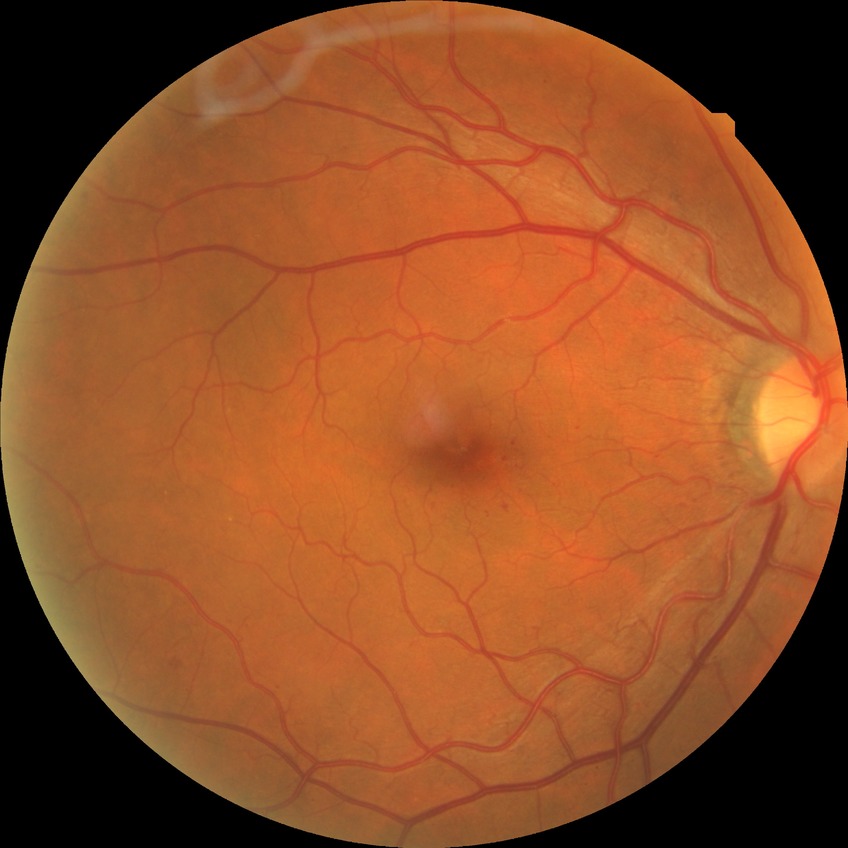

Assessment:
– DR class: non-proliferative diabetic retinopathy
– diabetic retinopathy (DR): simple diabetic retinopathy (SDR)